Wide-field fundus image from infant ROP screening. 640 by 480 pixels
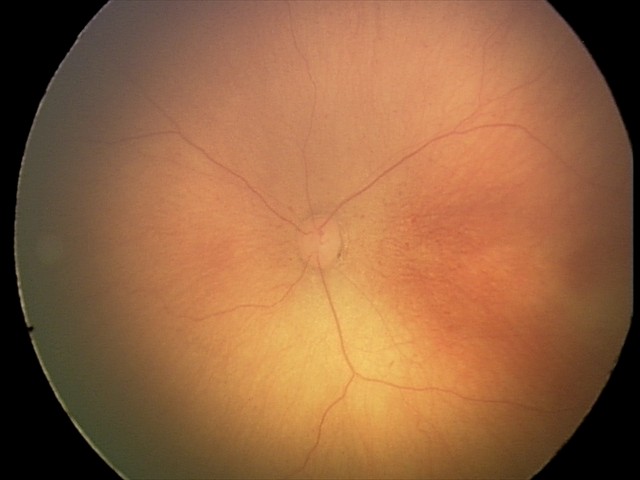 Impression: retinopathy of prematurity stage 0 — incomplete retinal vascularization without a demarcation line; no plus disease.